848 by 848 pixels. Without pupil dilation. NIDEK AFC-230. Retinal fundus photograph. Modified Davis grading — 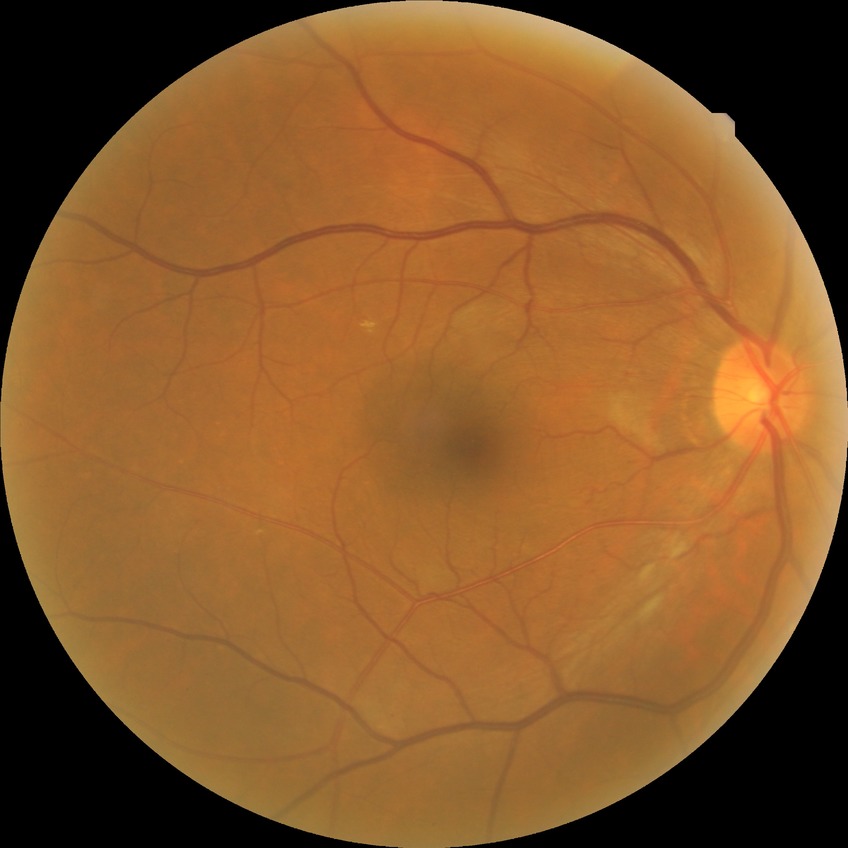 Modified Davis grading: simple diabetic retinopathy.